Optic disc photograph — 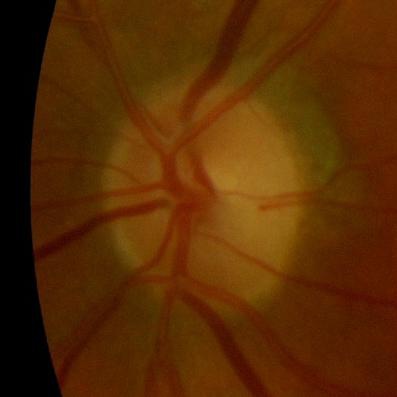 Demonstrates no glaucomatous findings.